Retinal fundus photograph: 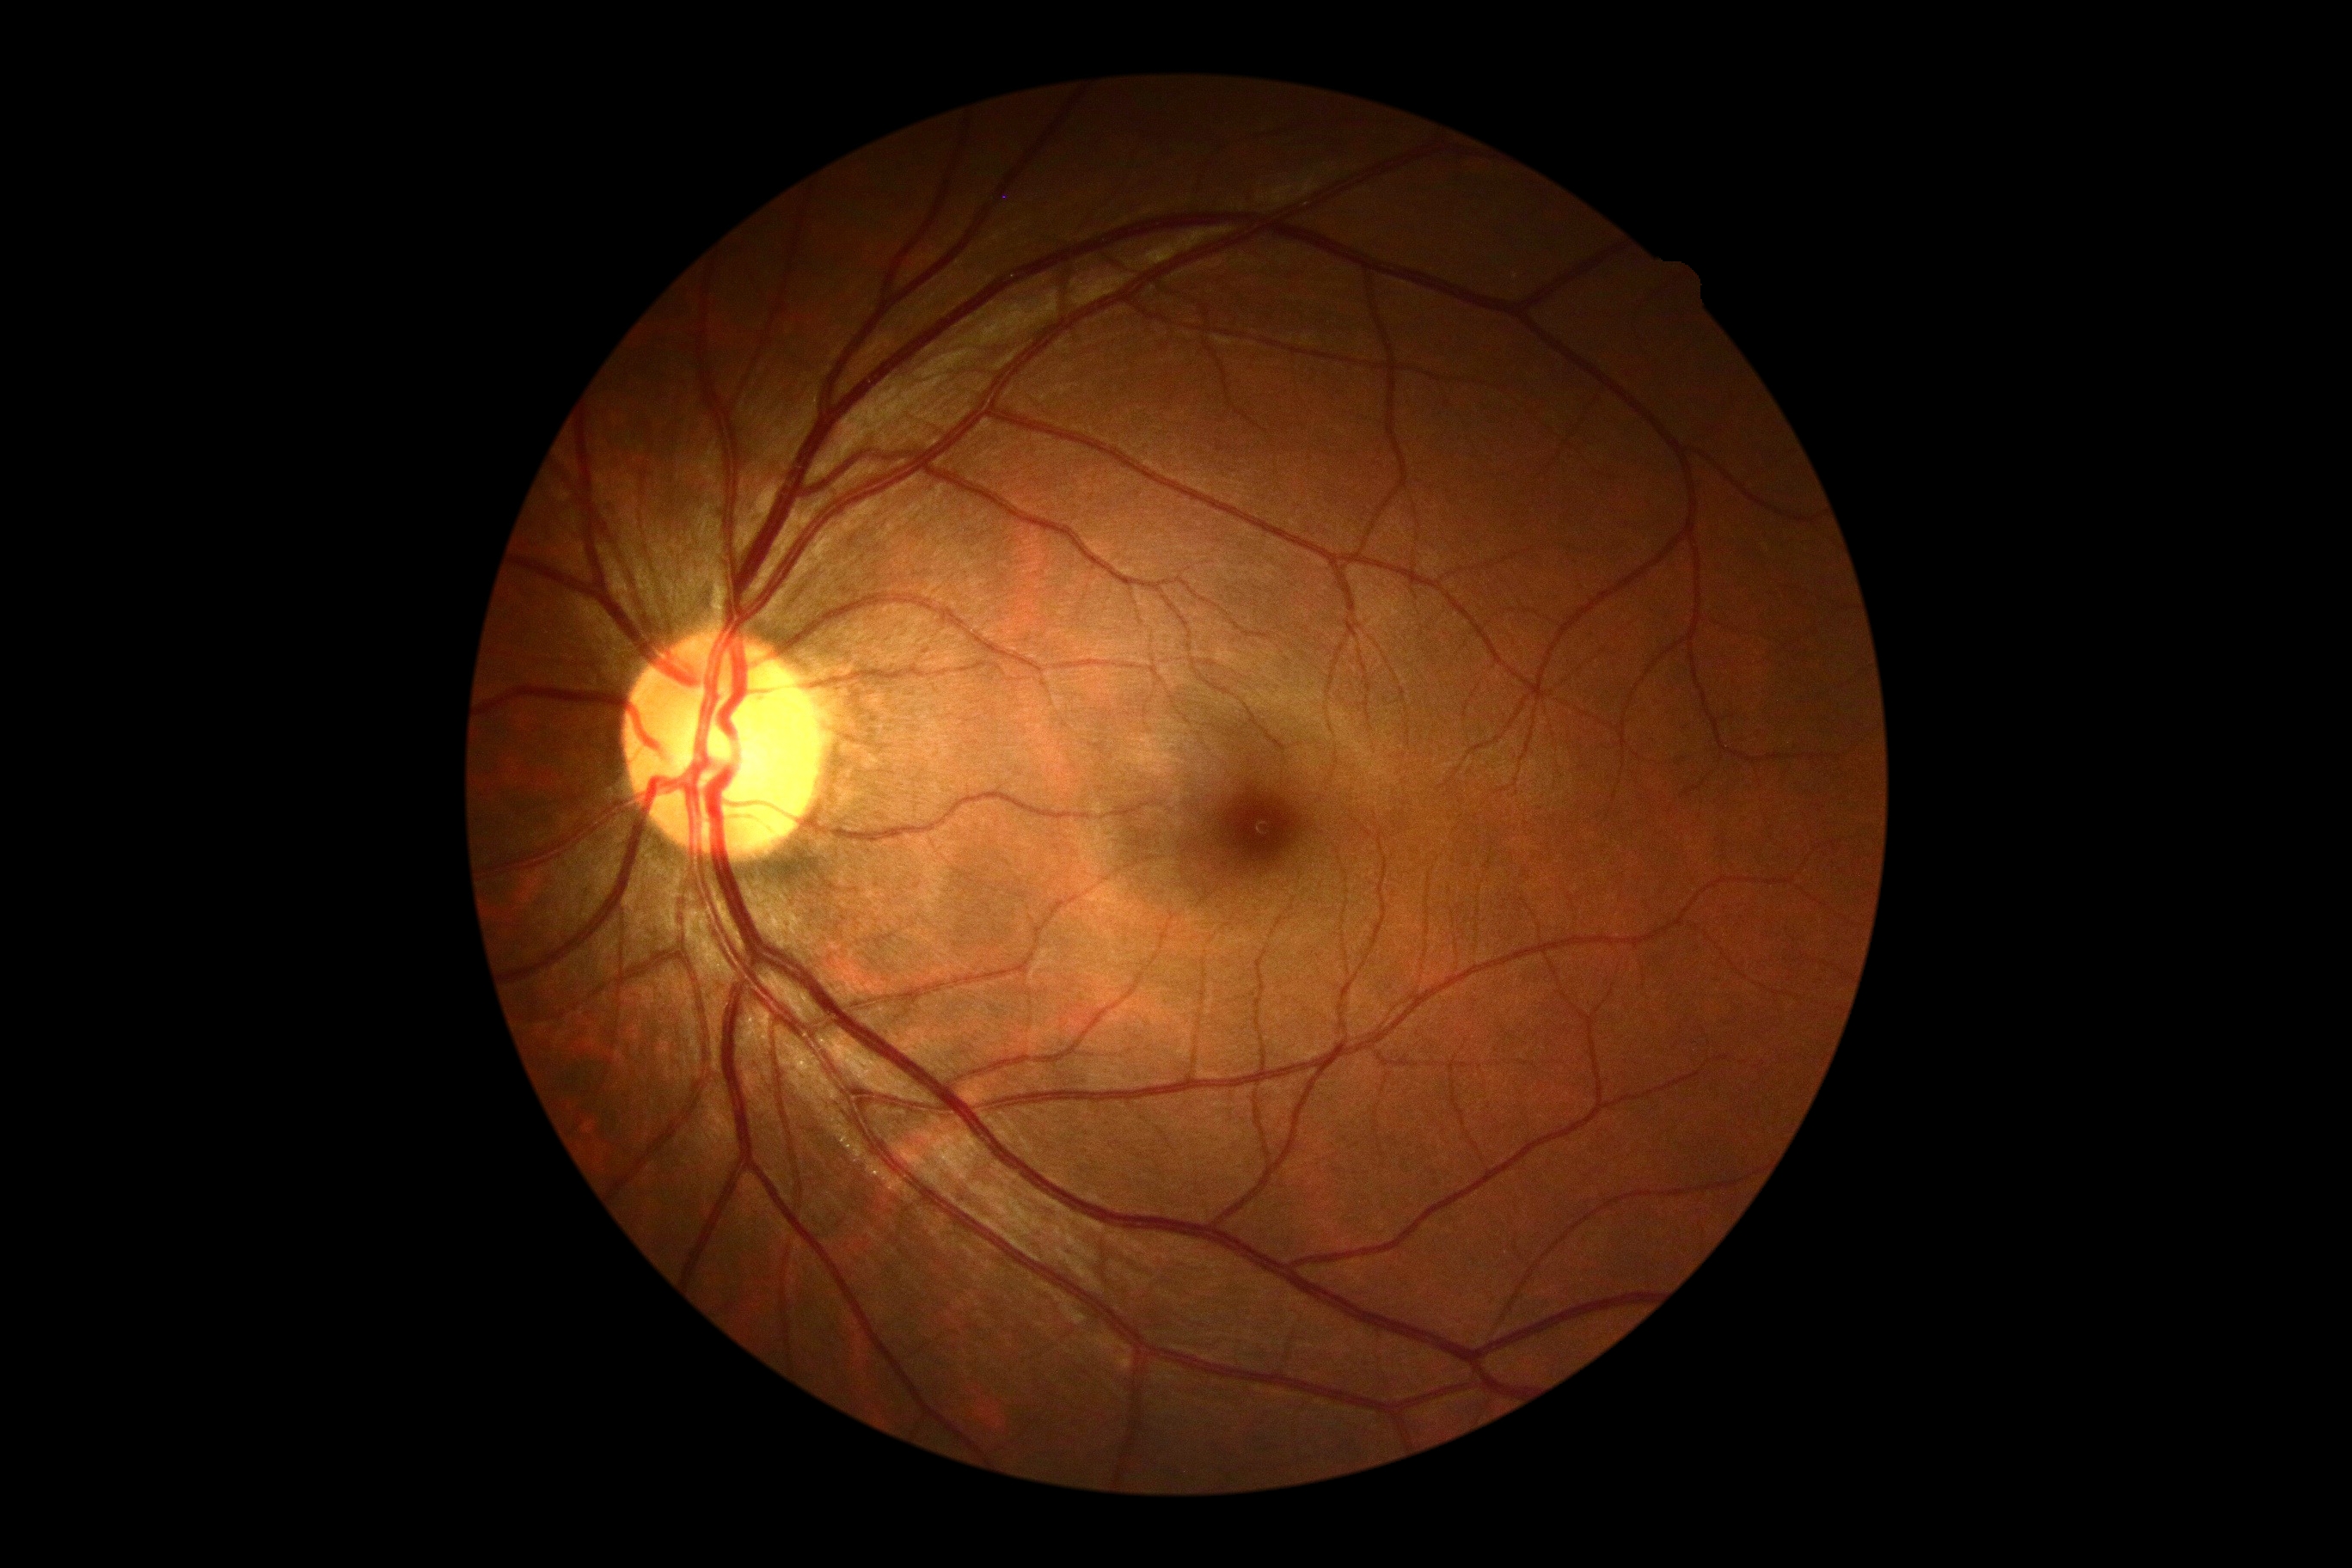 Diabetic retinopathy (DR): grade 0 (no apparent retinopathy).